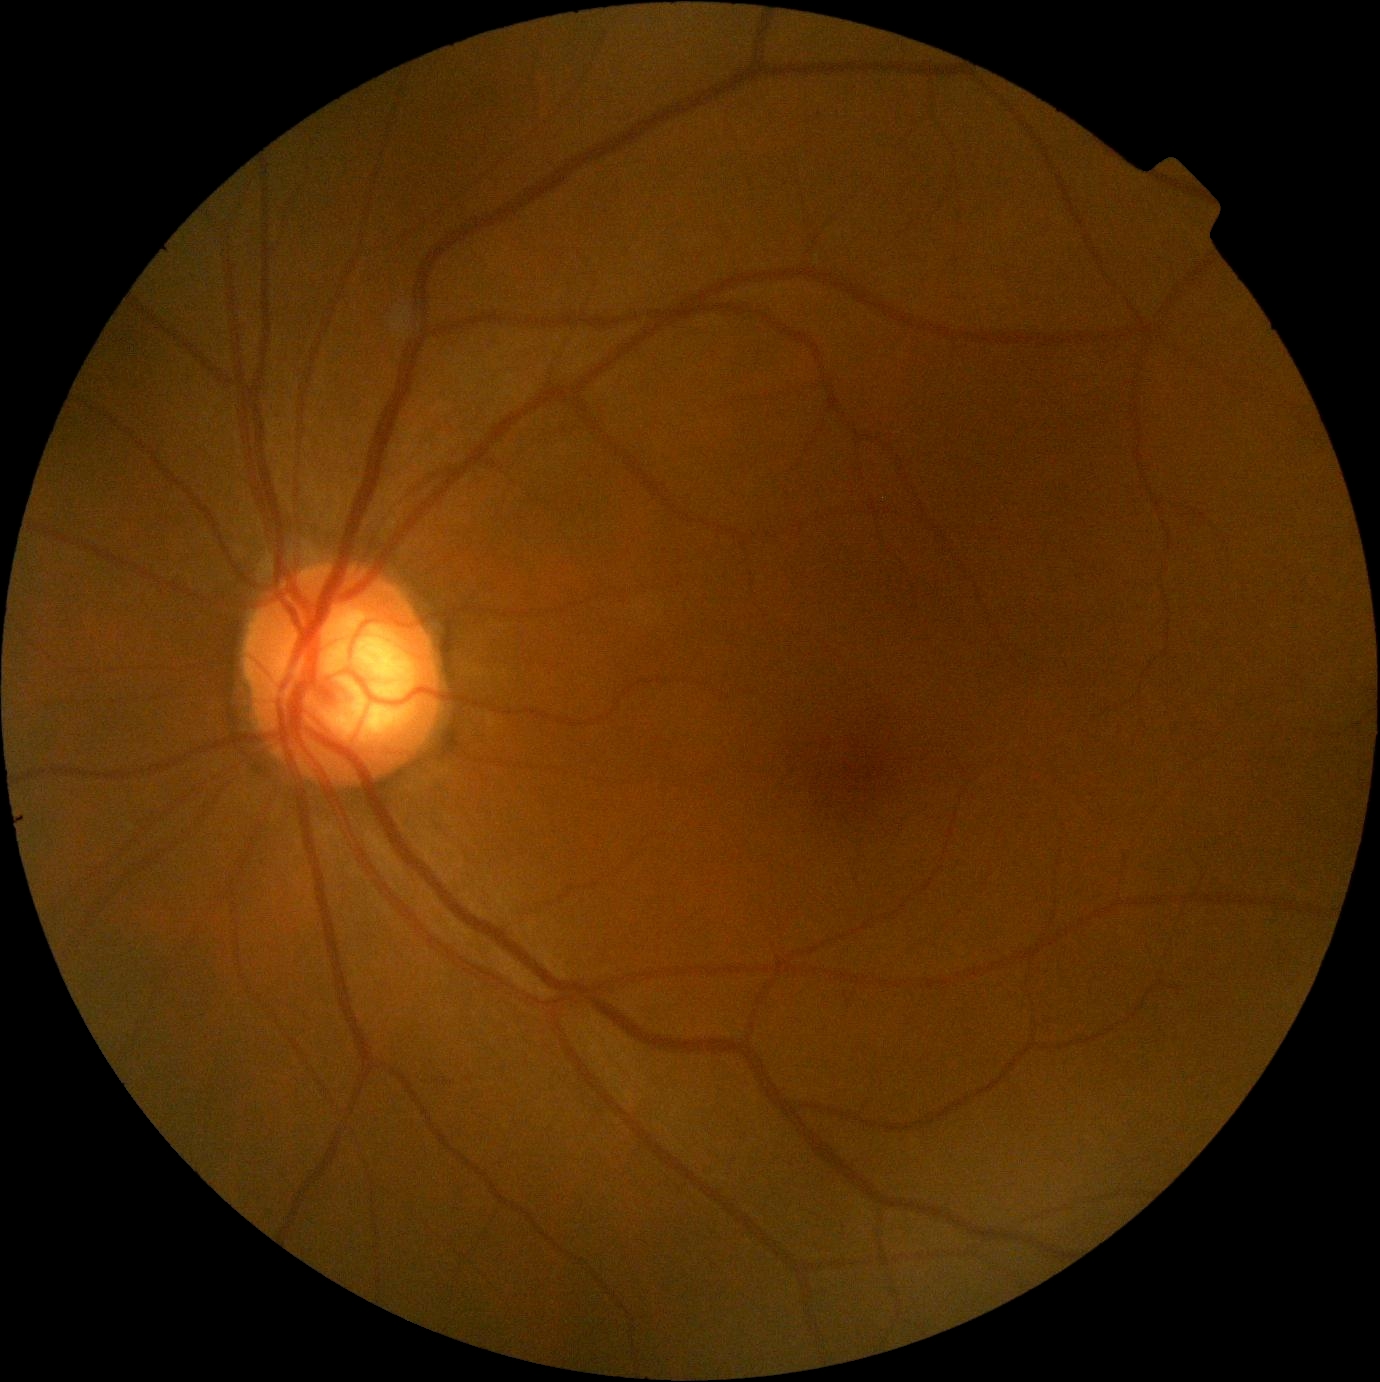 DR impression = no signs of DR
diabetic retinopathy severity = grade 0